Color fundus photograph — 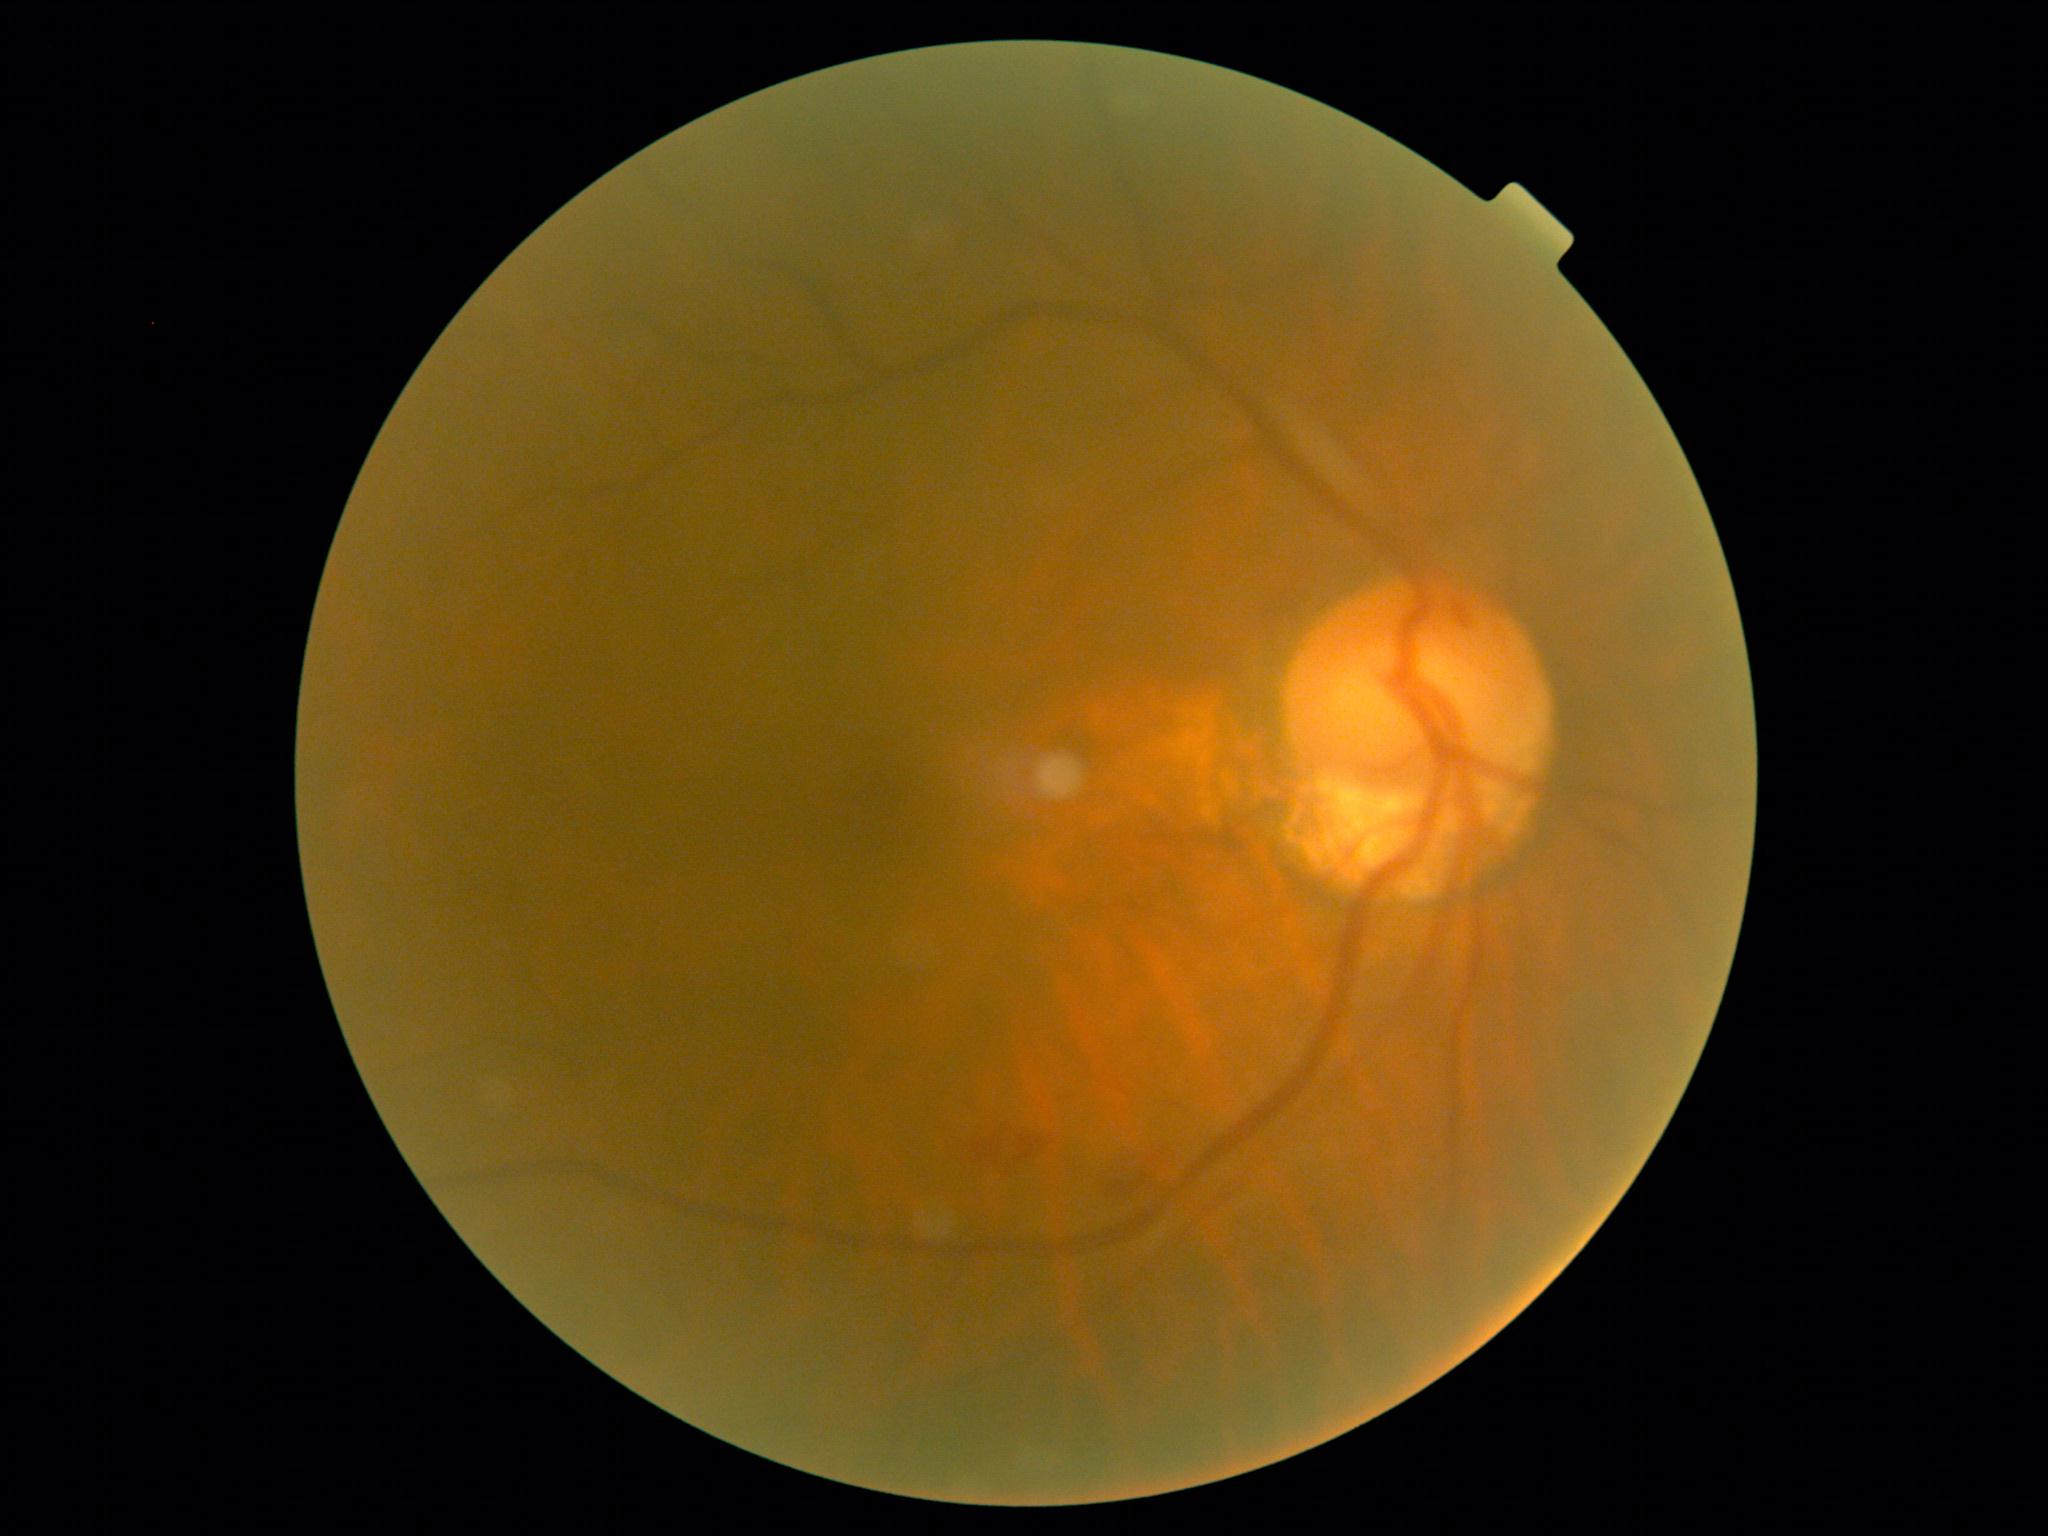

DR: grade 2 (moderate NPDR), DR class: non-proliferative diabetic retinopathy.